Modified Davis grading: 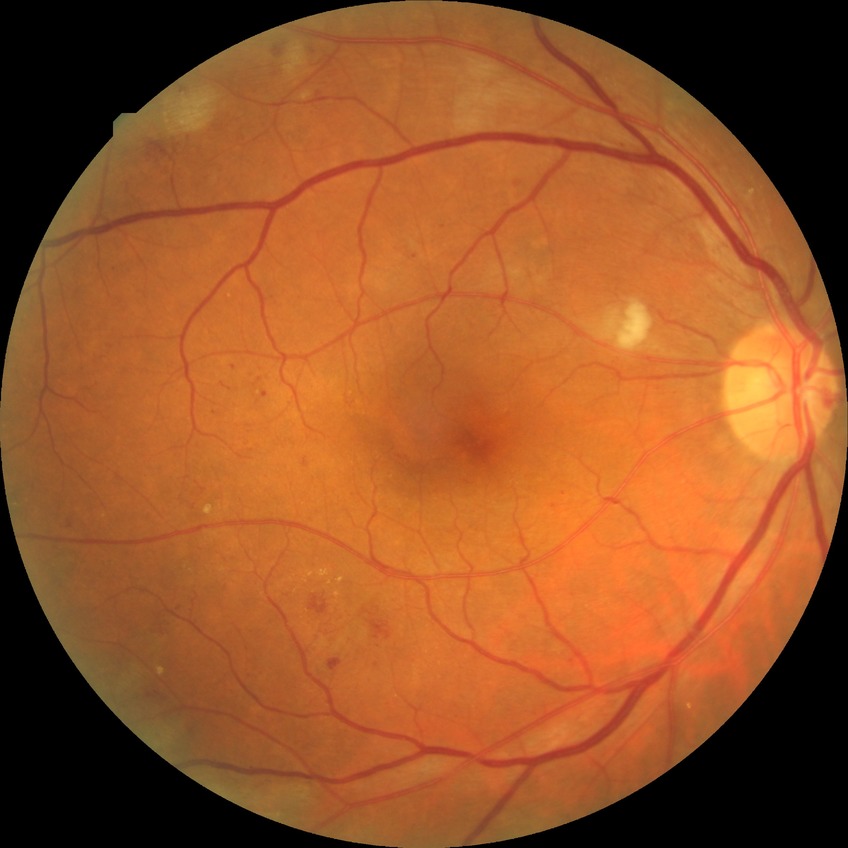 Davis grading is pre-proliferative diabetic retinopathy. Disease class: non-proliferative diabetic retinopathy.